Color fundus image — 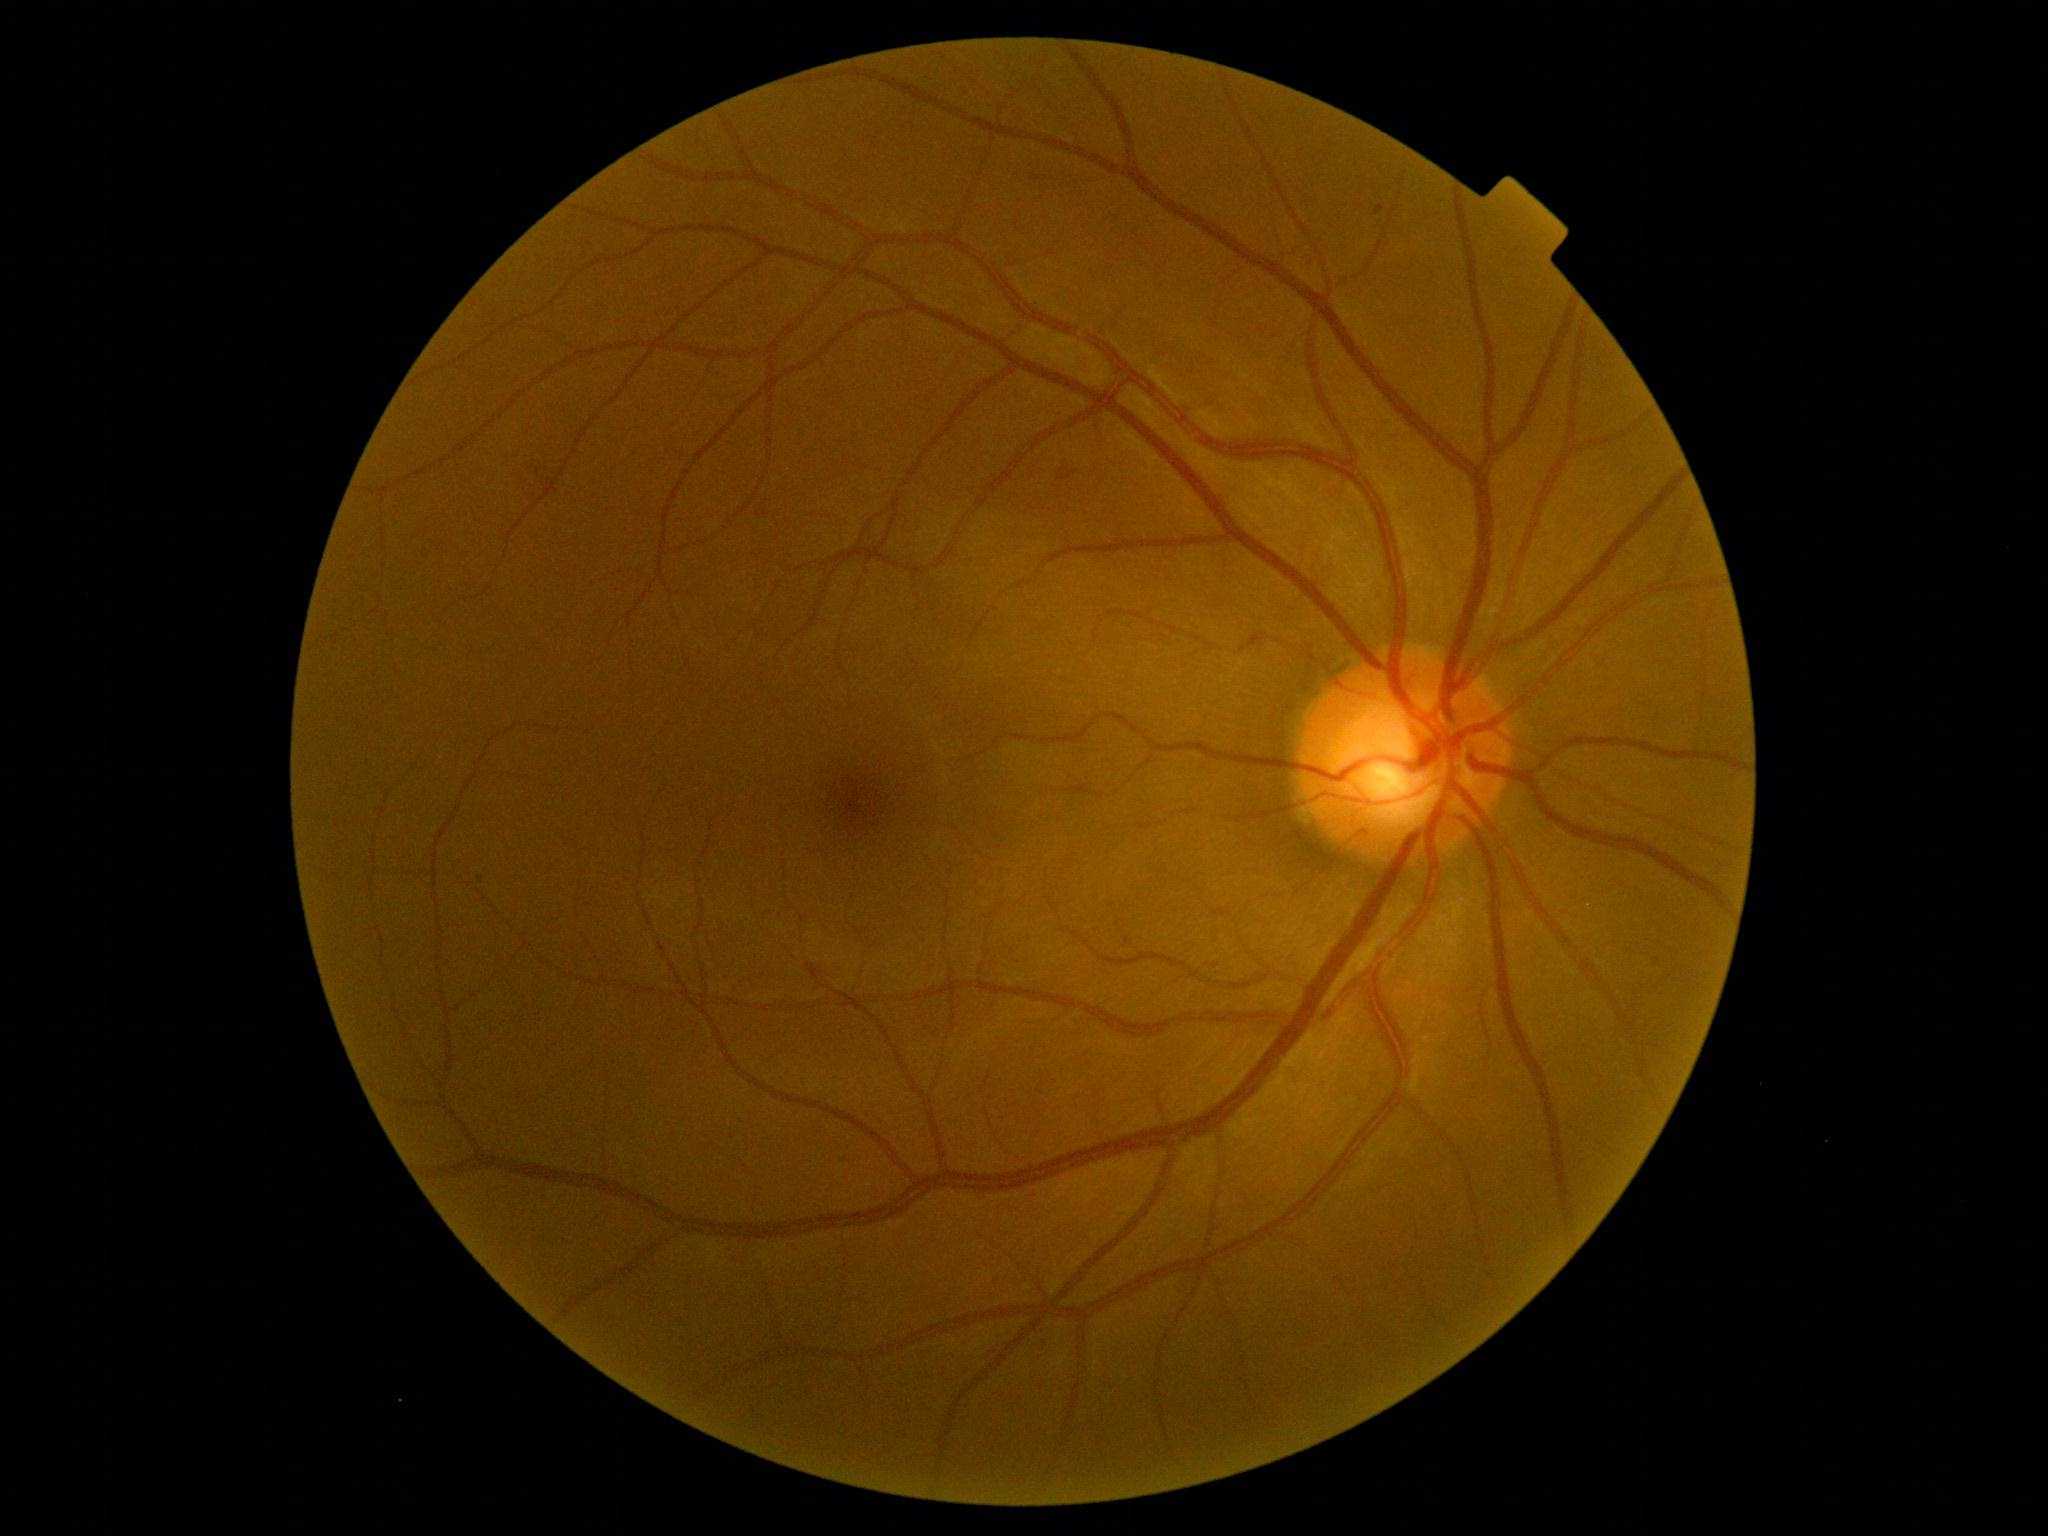
DR severity: grade 2
SEs: none
HEs: none
EXs: none
MAs: {"left": 1375, "top": 206, "right": 1384, "bottom": 216}